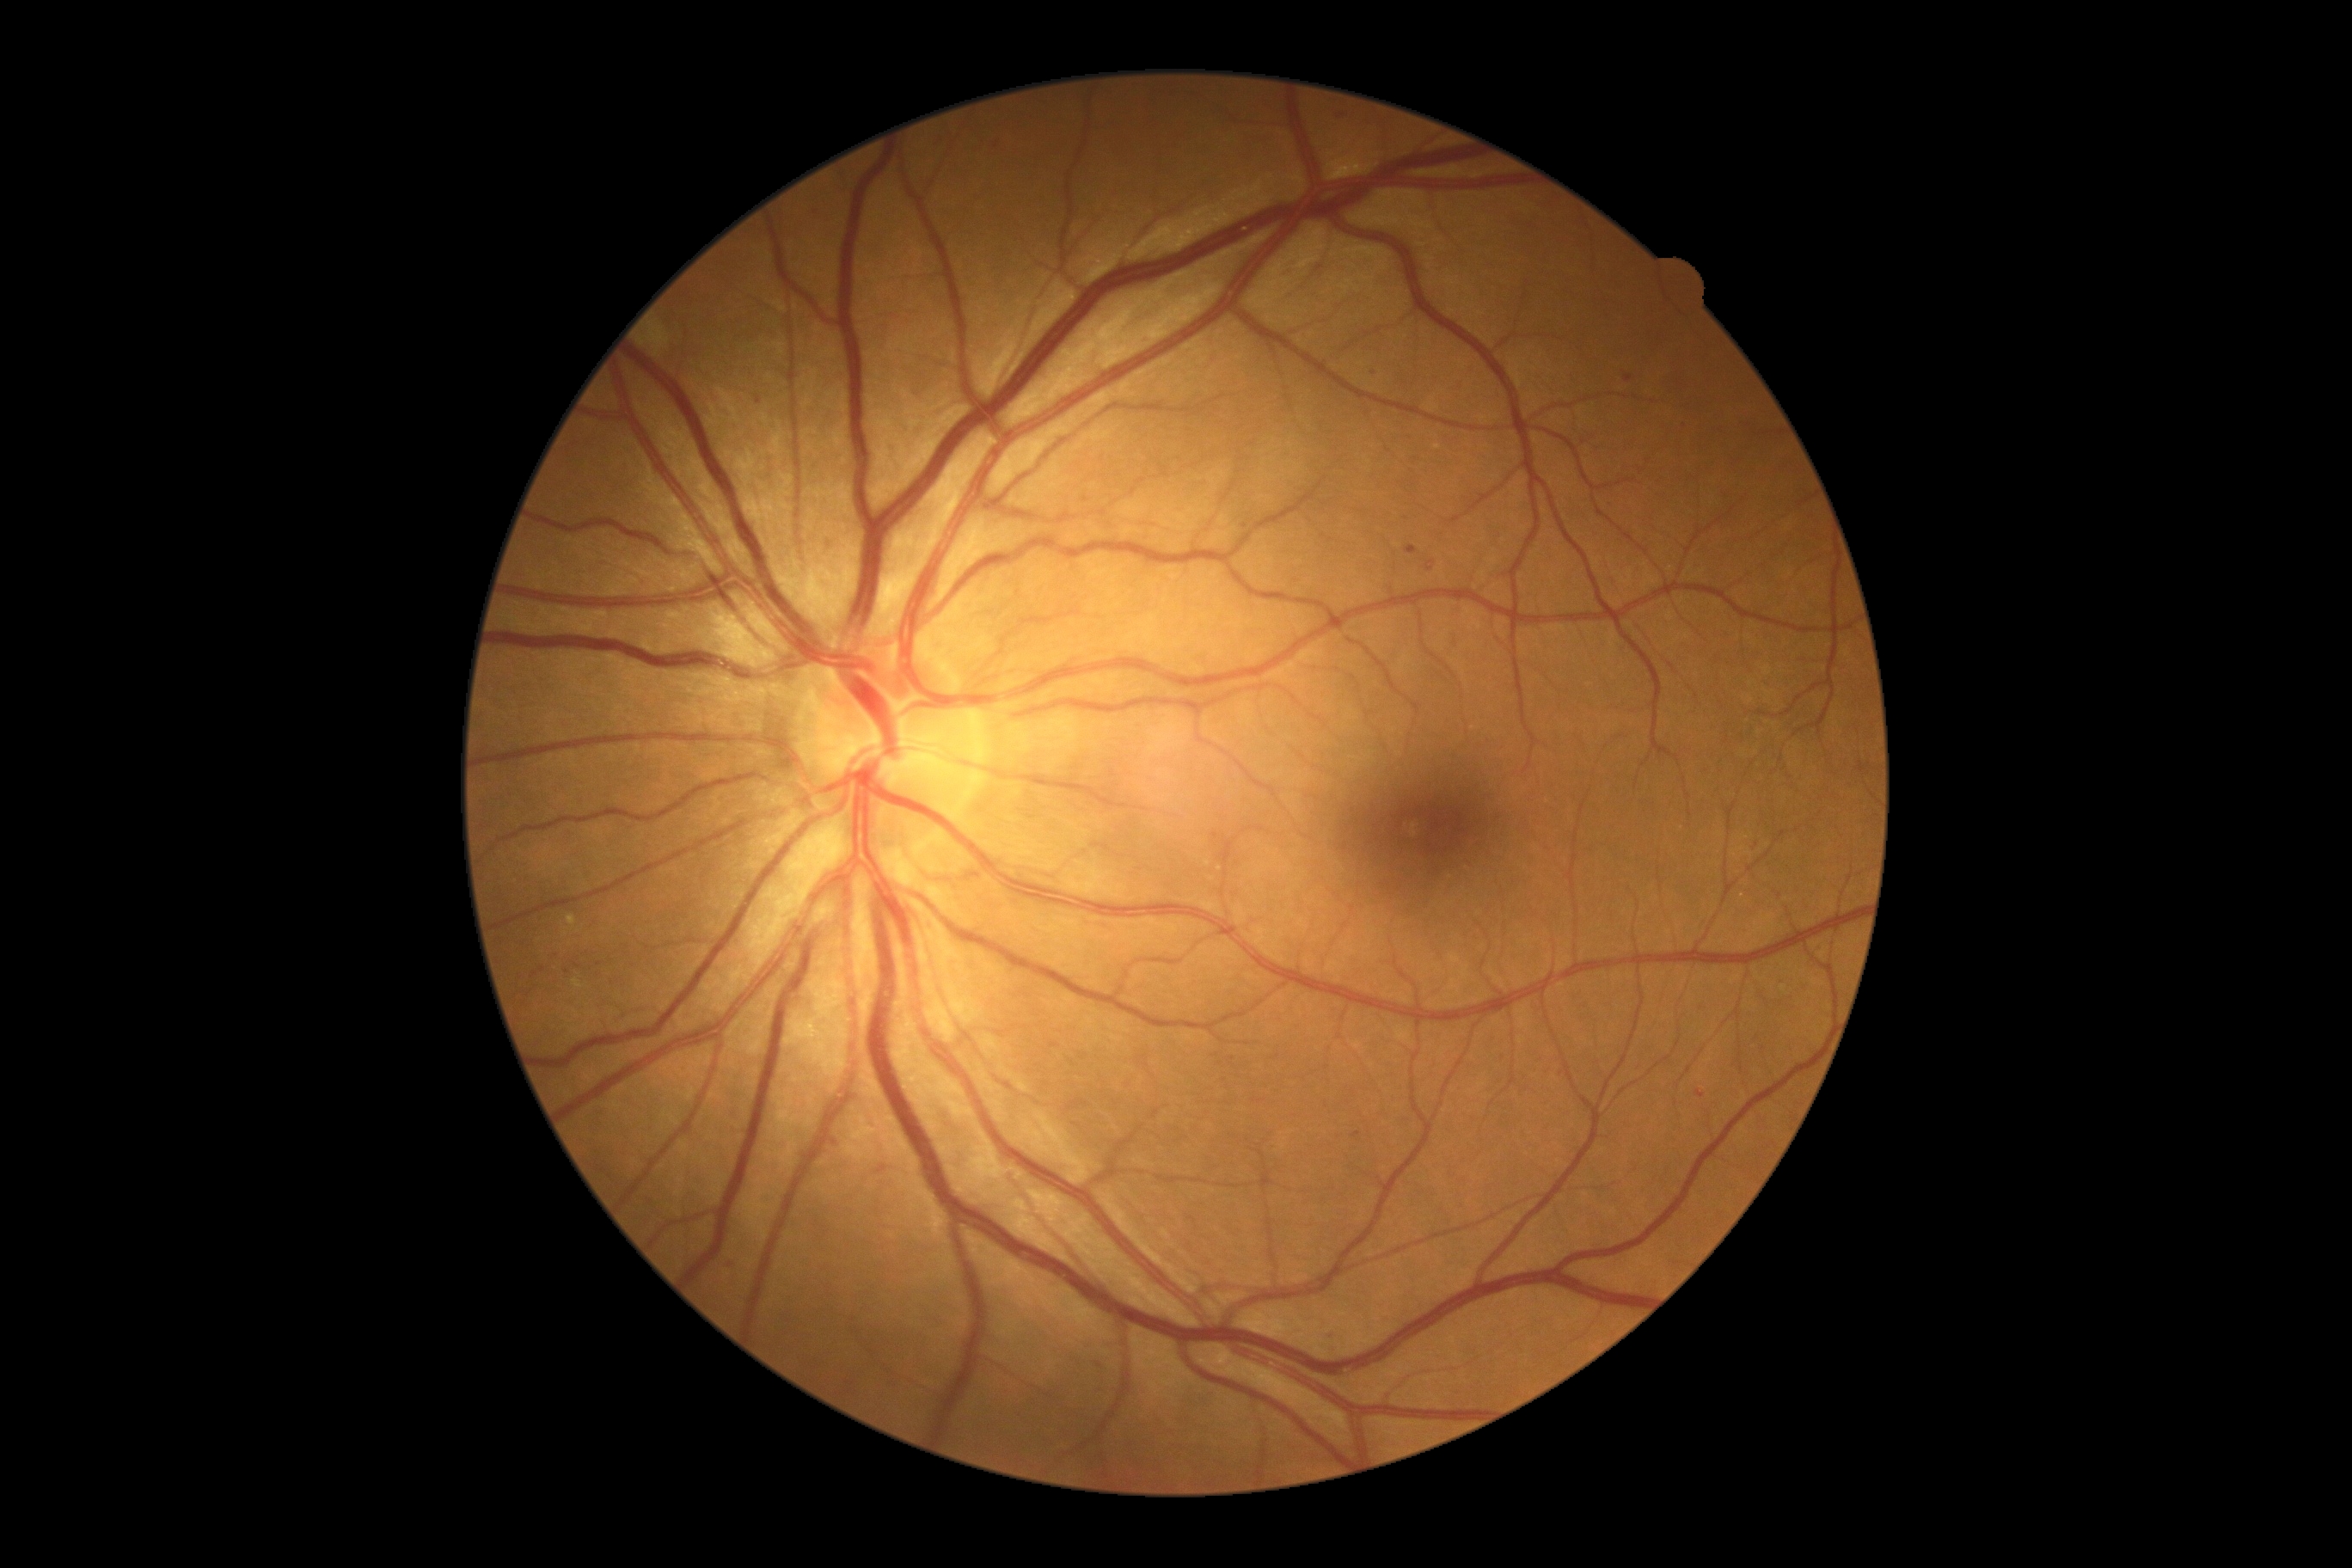
Retinopathy grade is 2 (moderate NPDR).